Modified Davis classification. CFP. 45-degree field of view.
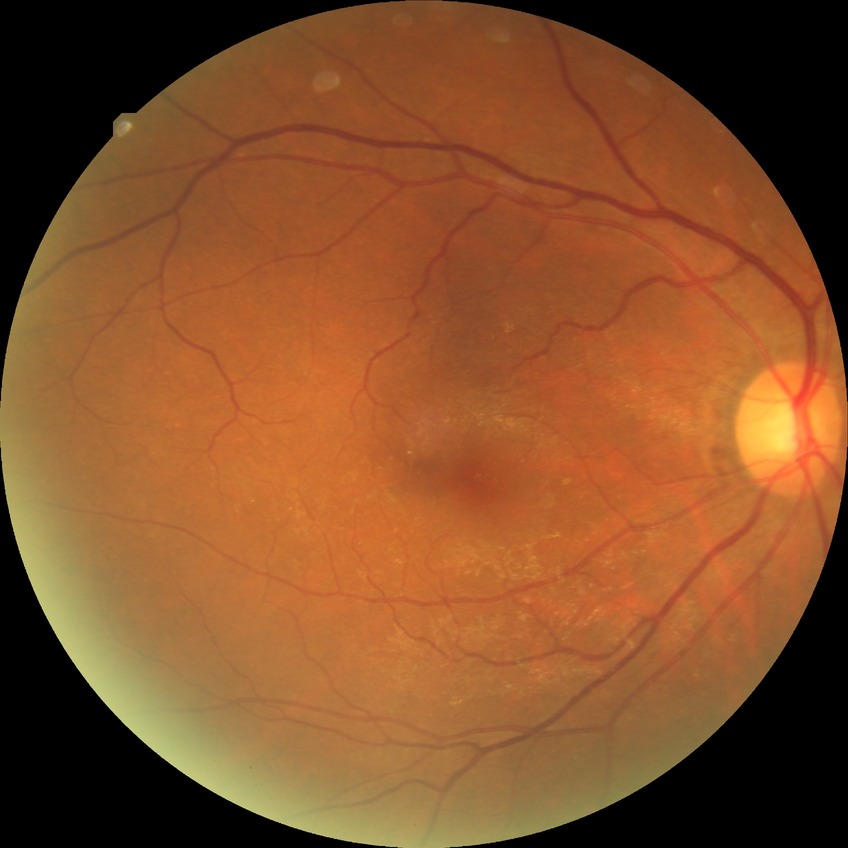
{"davis_grade": "NDR"}